Color fundus image. 2352x1568px
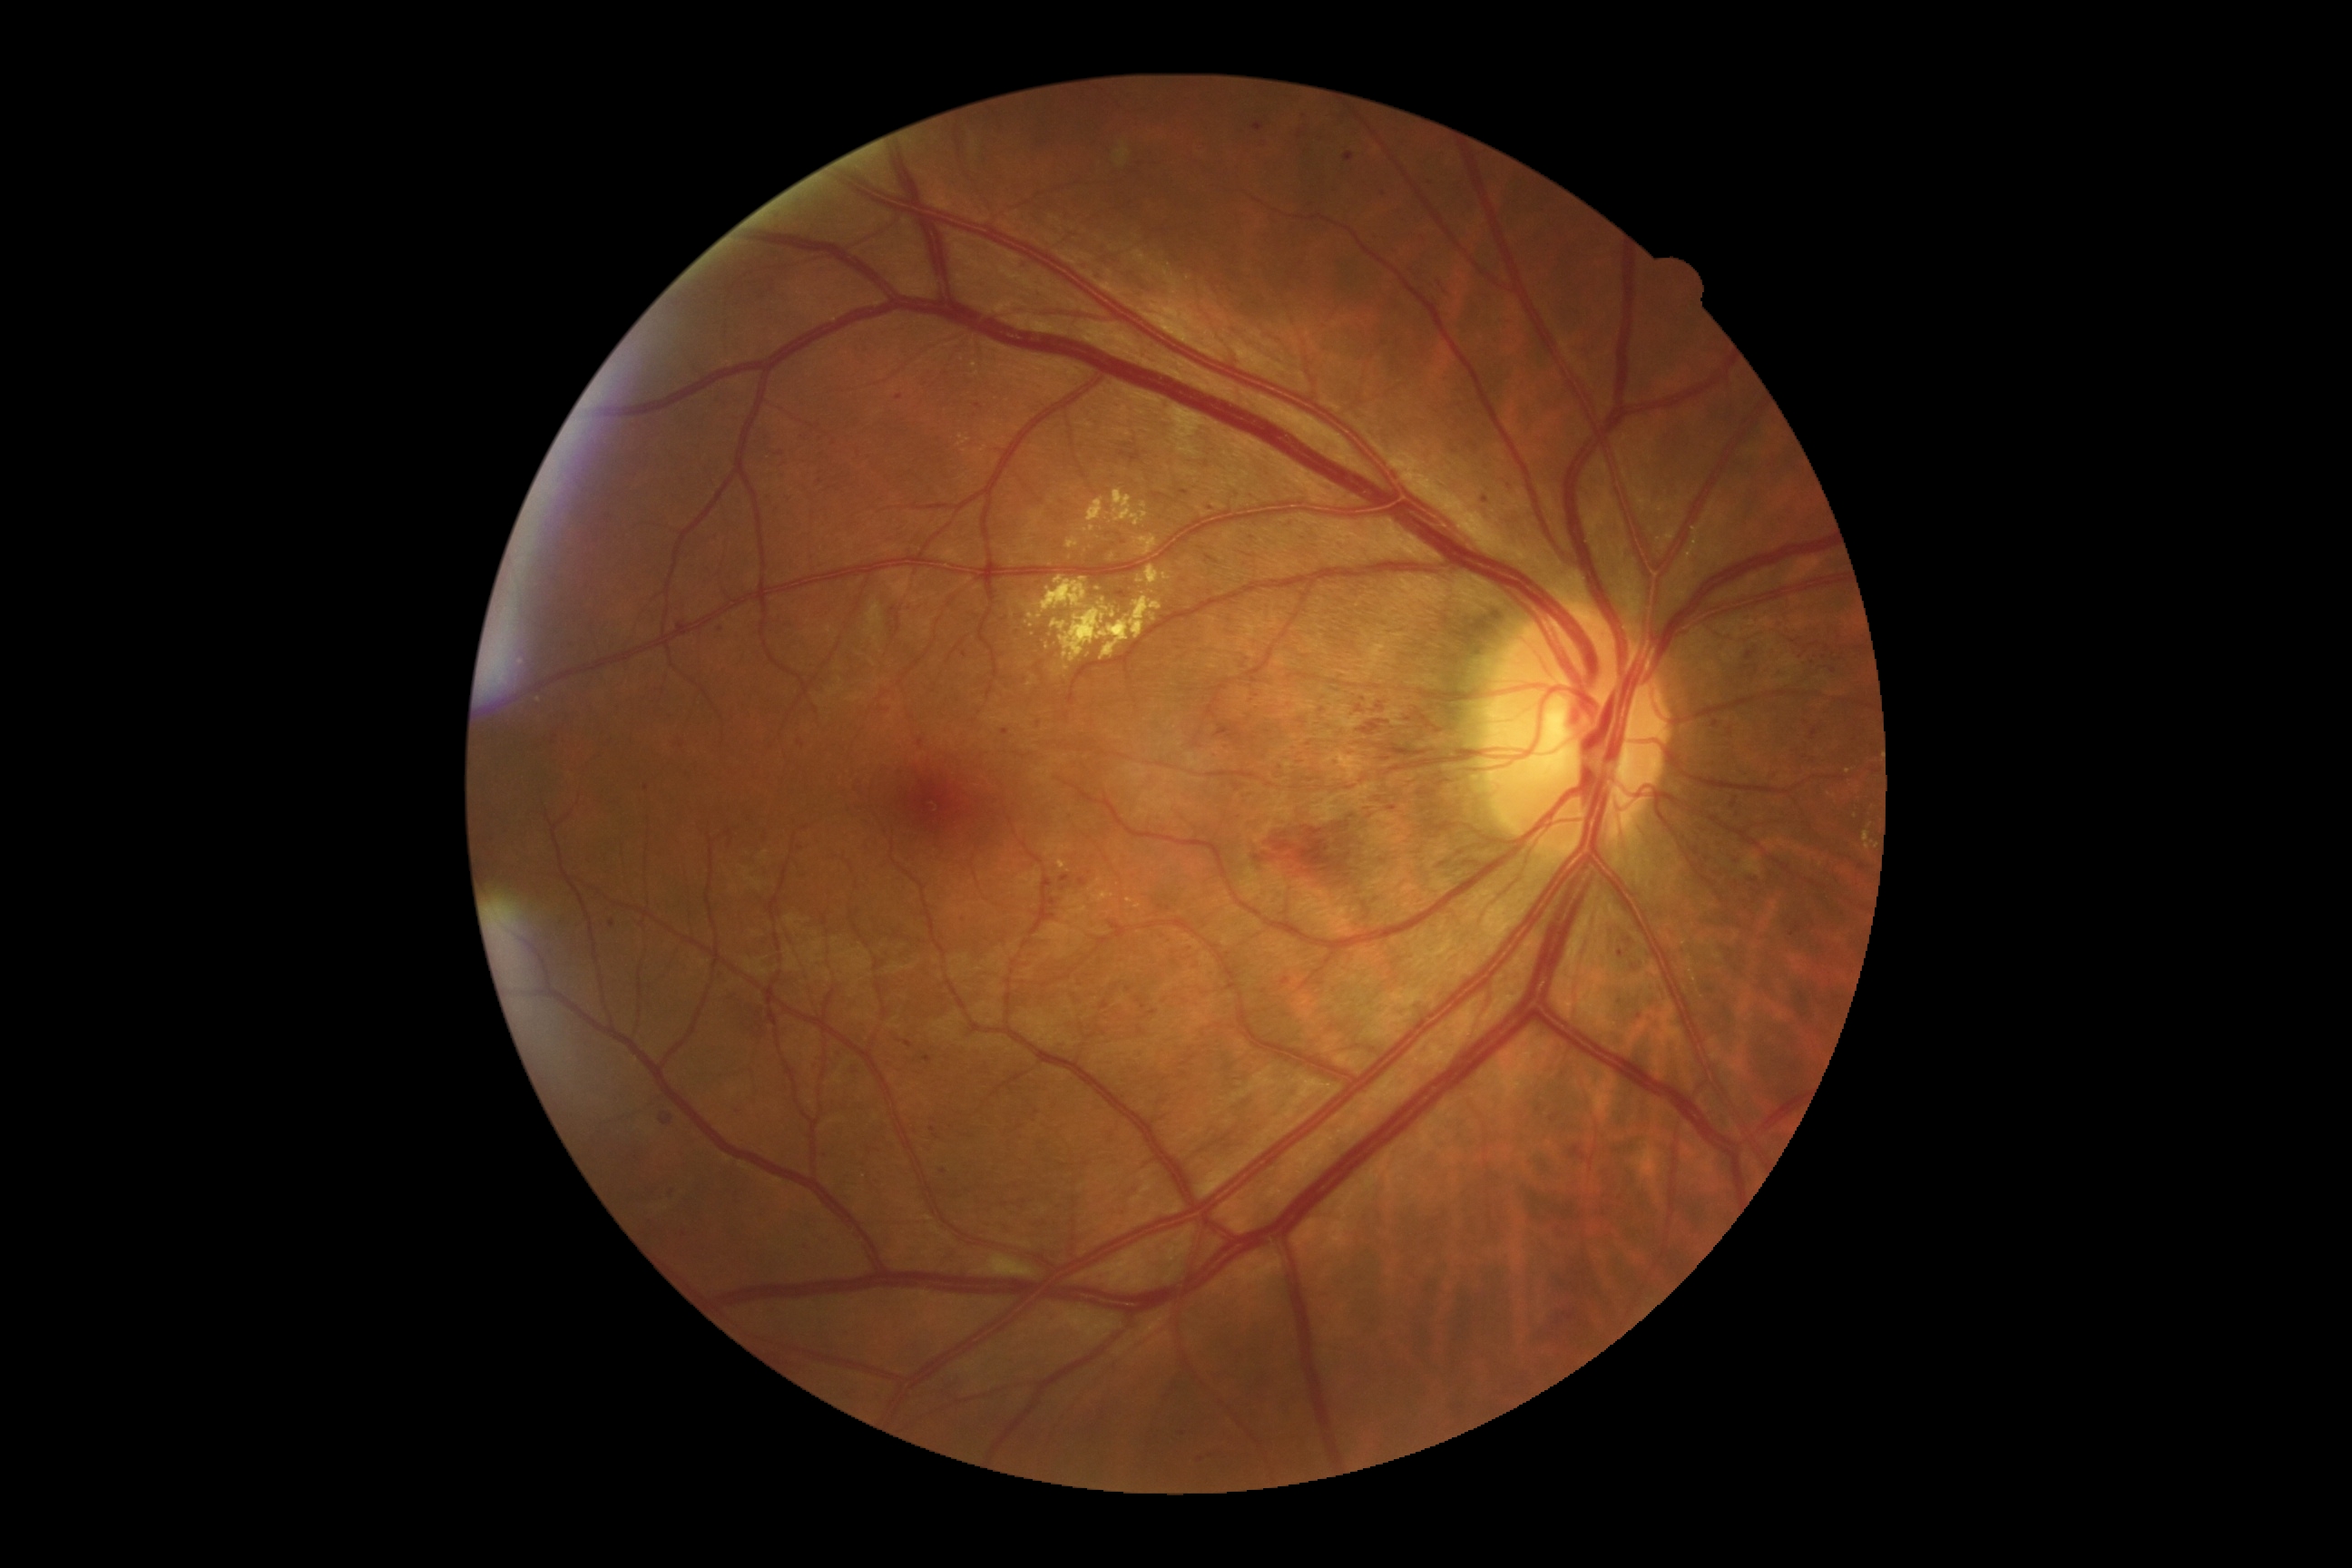 partial: true
dr_grade: 3
dr_grade_name: severe NPDR
lesions:
  he:
    - bbox=[1101, 1001, 1110, 1010]
    - bbox=[1115, 591, 1130, 600]
    - bbox=[553, 736, 558, 745]
    - bbox=[1083, 1161, 1092, 1168]
    - bbox=[1137, 997, 1148, 1010]
    - bbox=[1280, 977, 1291, 986]
    - bbox=[723, 828, 736, 852]
    - bbox=[1393, 210, 1407, 222]
    - bbox=[1745, 876, 1761, 890]
    - bbox=[1632, 1012, 1645, 1021]
    - bbox=[799, 435, 808, 442]
    - bbox=[1725, 792, 1747, 821]
  he_small:
    - 1037, 1112
    - 1509, 485
    - 933, 1129
    - 834, 444
    - 612, 924
    - 936, 1138